Diabetic retinopathy graded by the modified Davis classification.
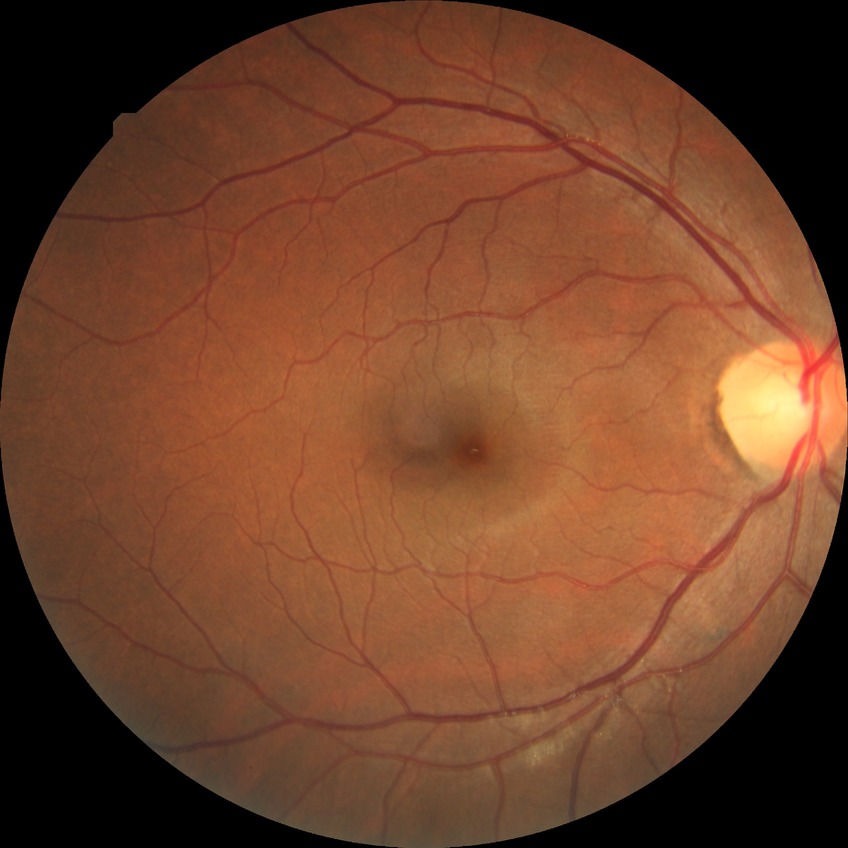

diabetic retinopathy (DR) = SDR (simple diabetic retinopathy)